Camera: Clarity RetCam 3 (130° FOV); infant wide-field retinal image:
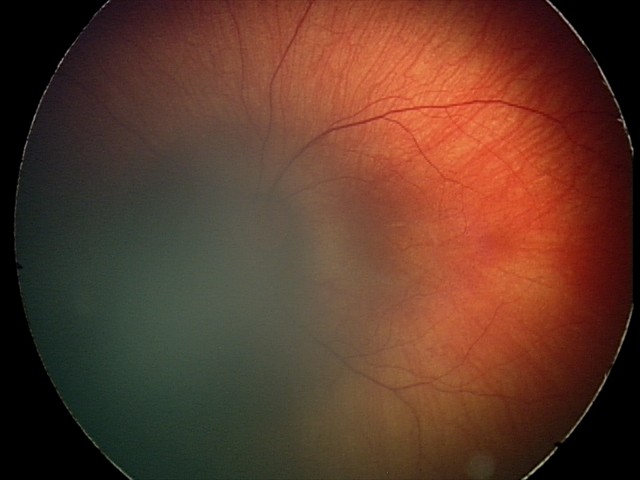 Impression: retinal hemorrhages.